45° FOV, 2352x1568px, color fundus image.
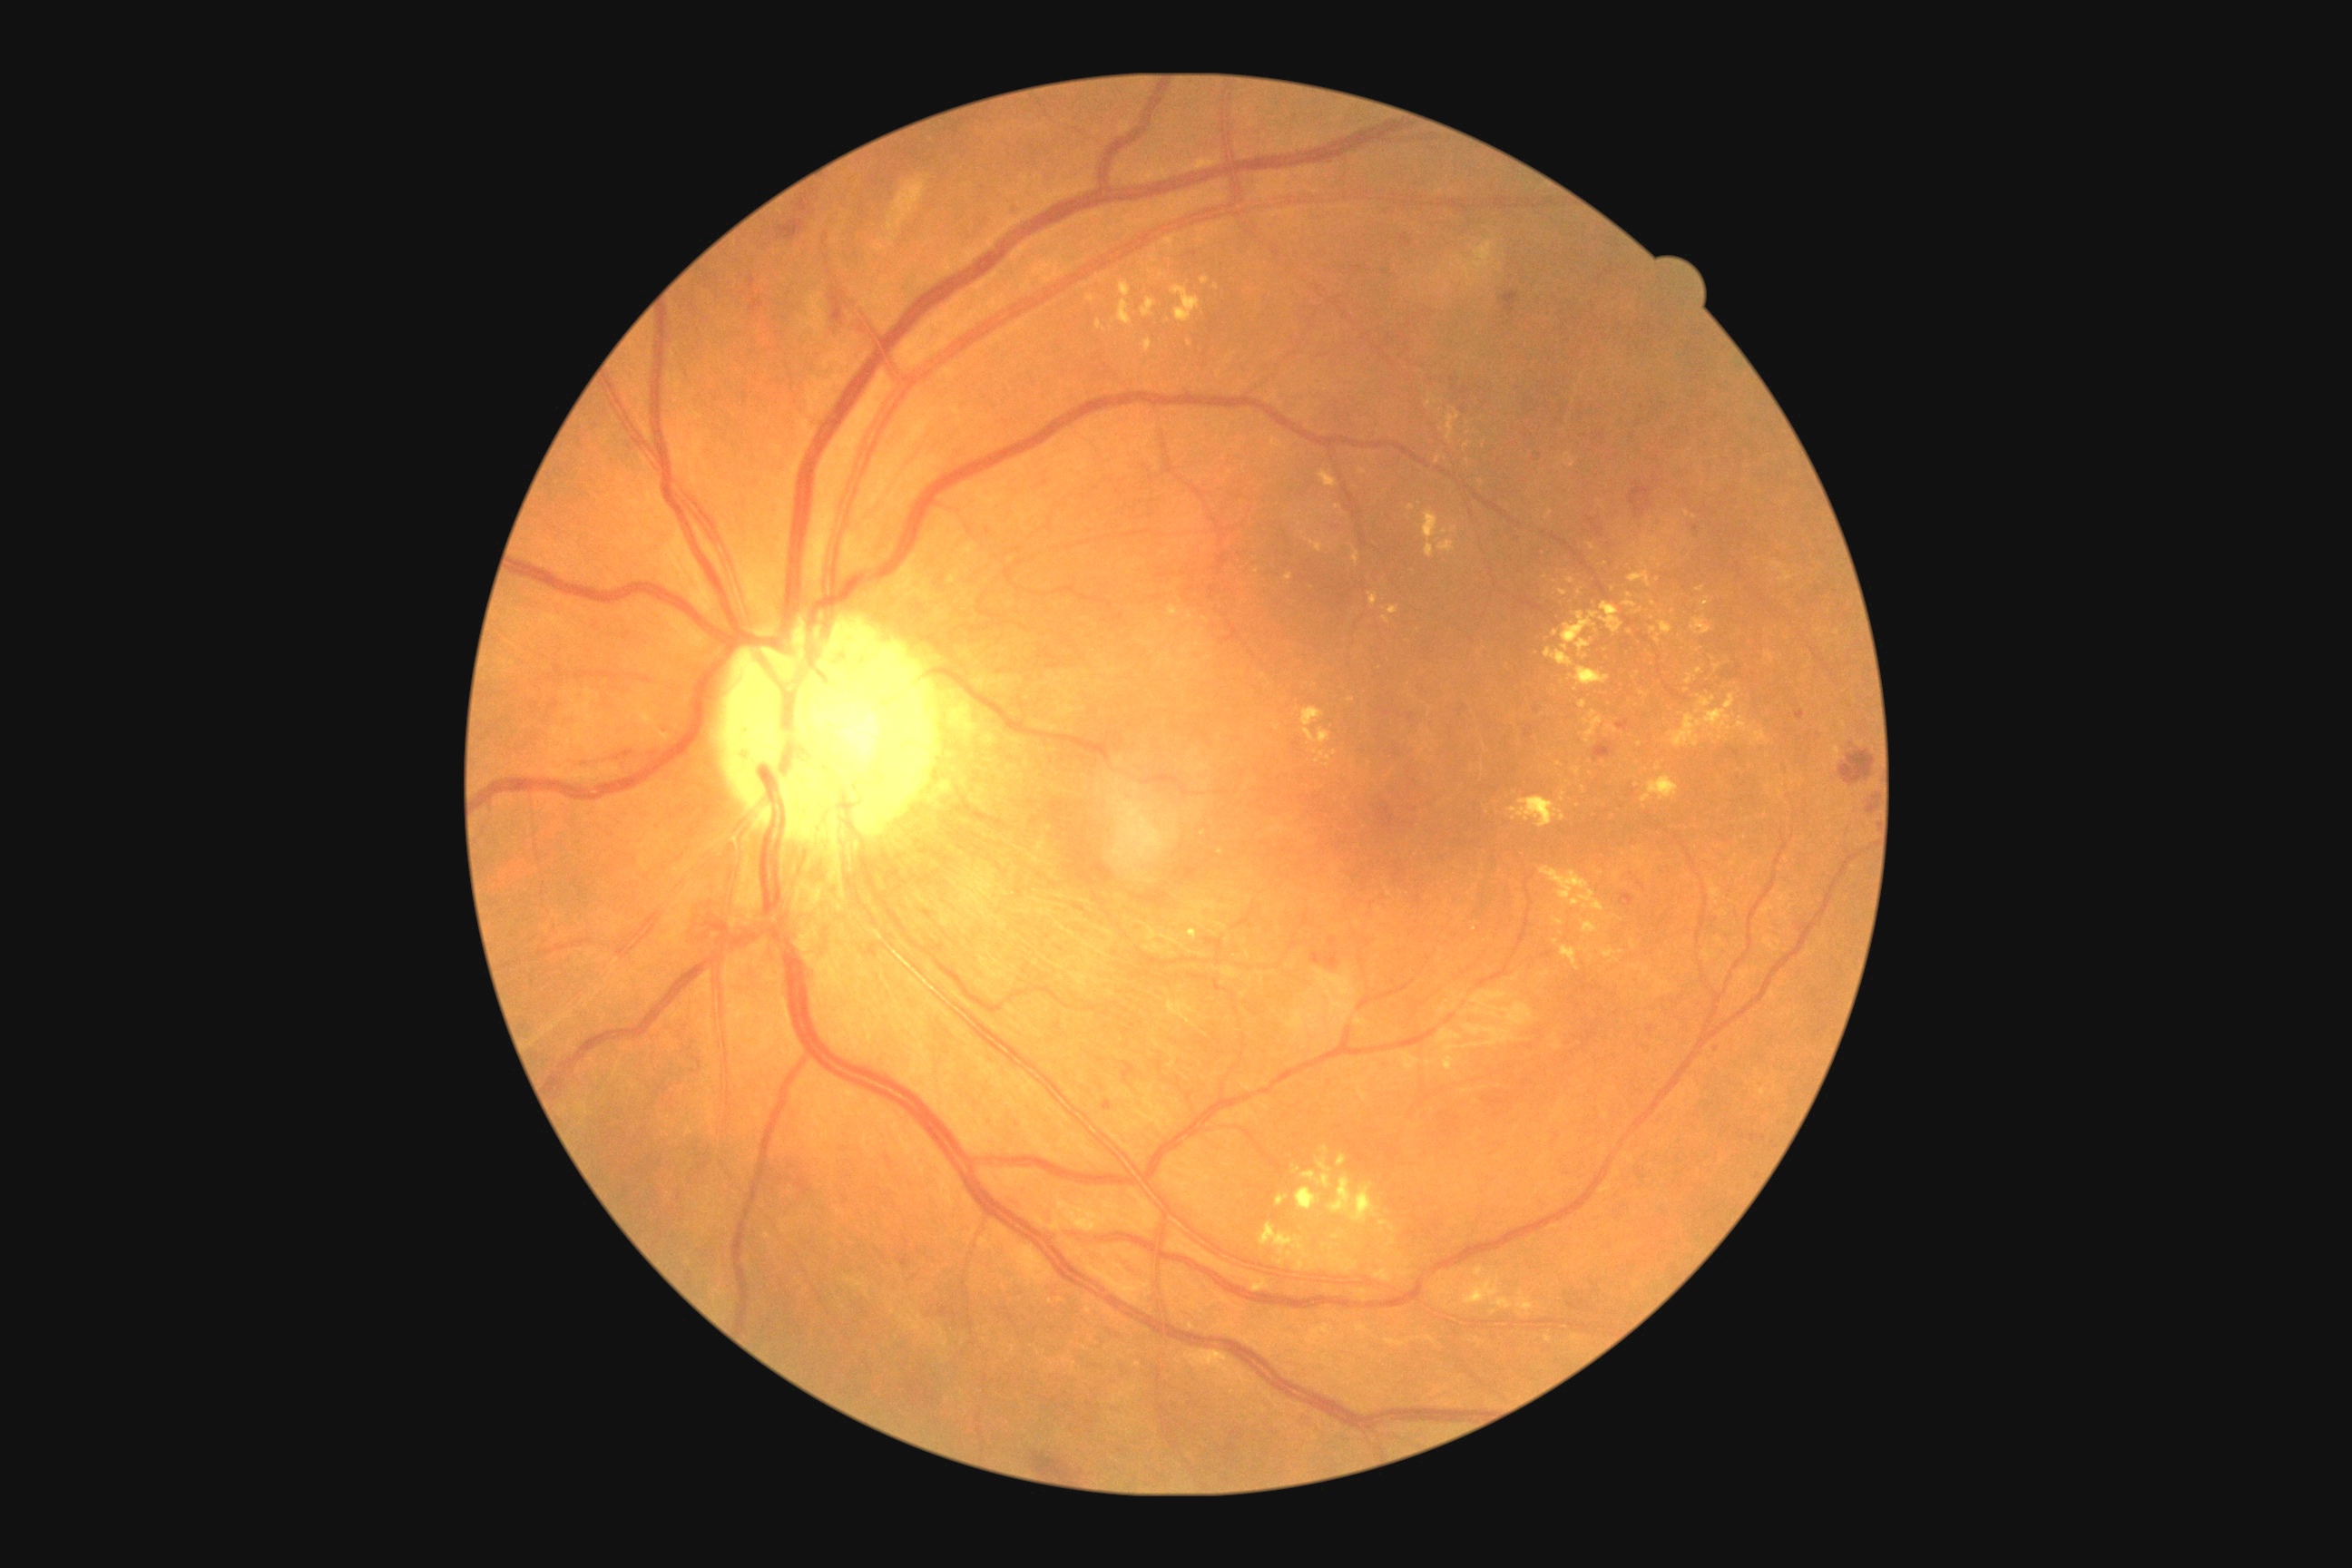

Diabetic retinopathy: grade 2 (moderate NPDR) — more than just microaneurysms but less than severe NPDR; non-proliferative diabetic retinopathy
Representative lesions:
hard exudates (continued) = <region>1573, 769, 1582, 776</region> | <region>1168, 605, 1179, 618</region> | <region>1097, 322, 1106, 333</region> | <region>1286, 574, 1293, 582</region> | <region>1302, 1159, 1333, 1190</region> | <region>1643, 966, 1651, 979</region> | <region>1567, 578, 1576, 583</region> | <region>1424, 509, 1438, 540</region> | <region>1582, 921, 1598, 934</region> | <region>1685, 674, 1692, 685</region> | <region>1329, 1175, 1378, 1224</region> | <region>1634, 848, 1642, 854</region> | <region>1603, 948, 1623, 963</region>
Hard exudates (small, approximate centers) near 1318/761 | 1475/929 | 1687/513 | 1393/1241 | 1630/632 | 1351/700 | 1772/565